45-degree field of view:
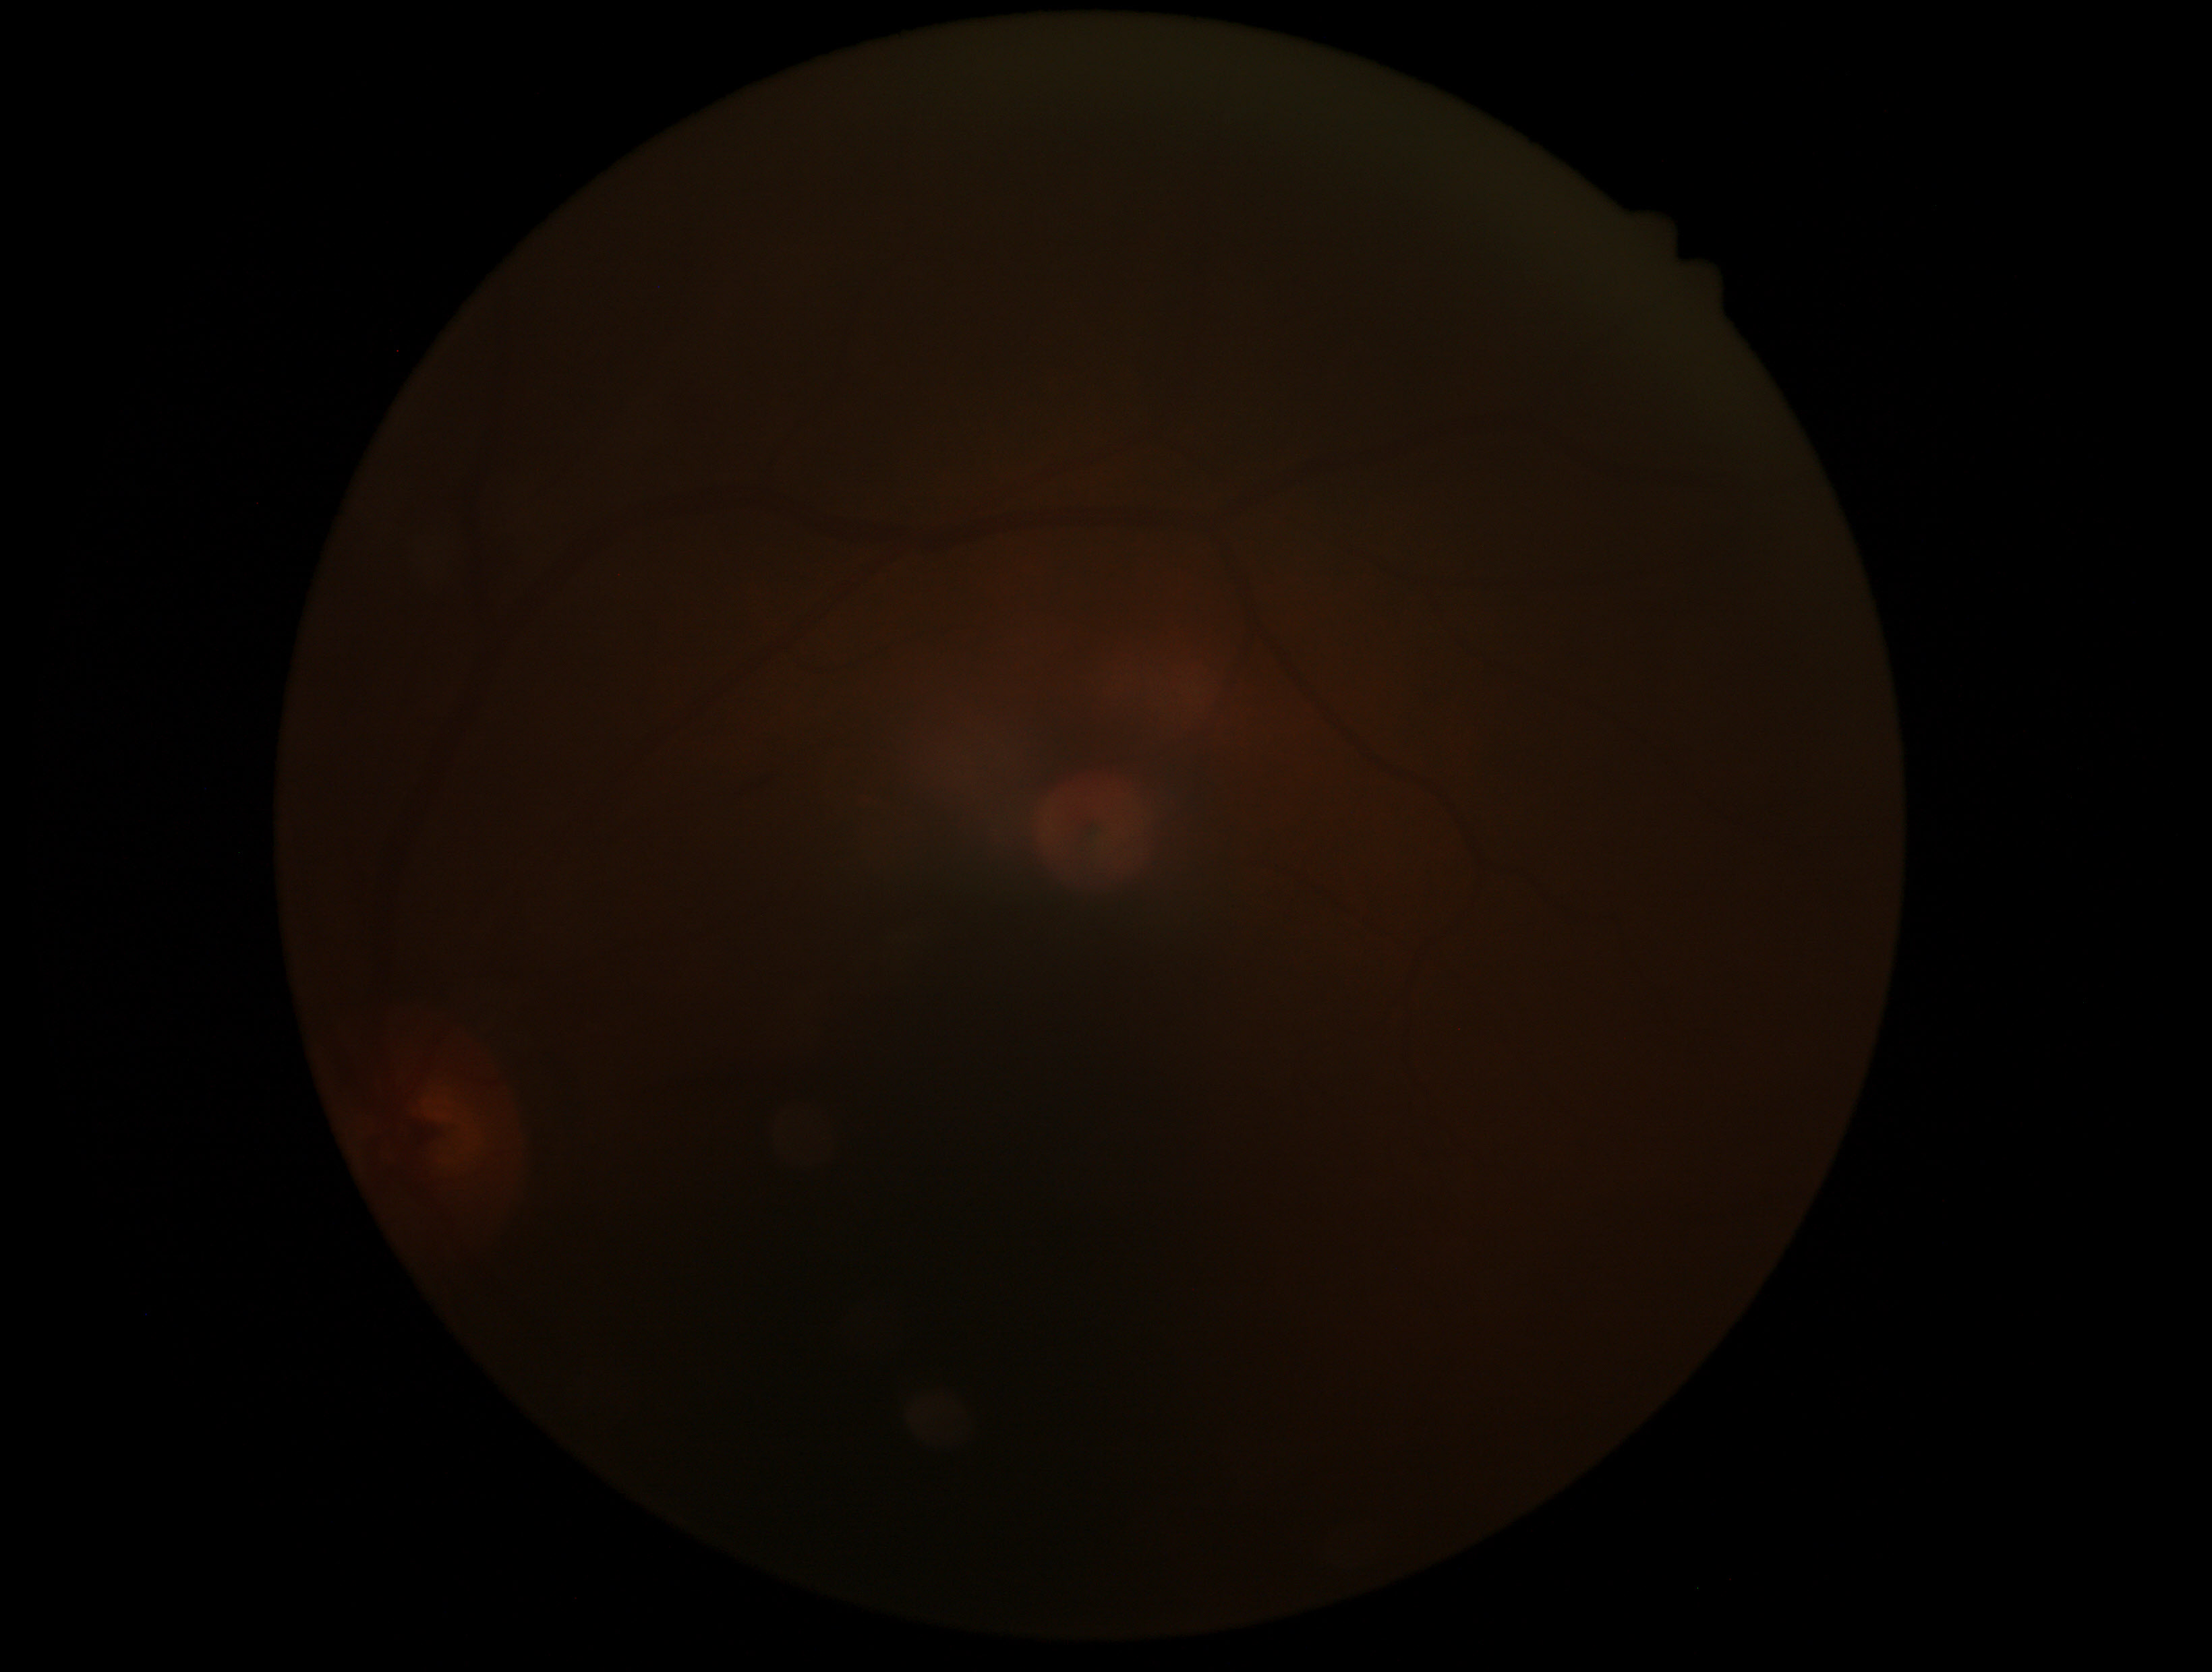
DR: ungradable due to poor image quality.